Pediatric wide-field fundus photograph; camera: Natus RetCam Envision (130° FOV); 1440x1080: 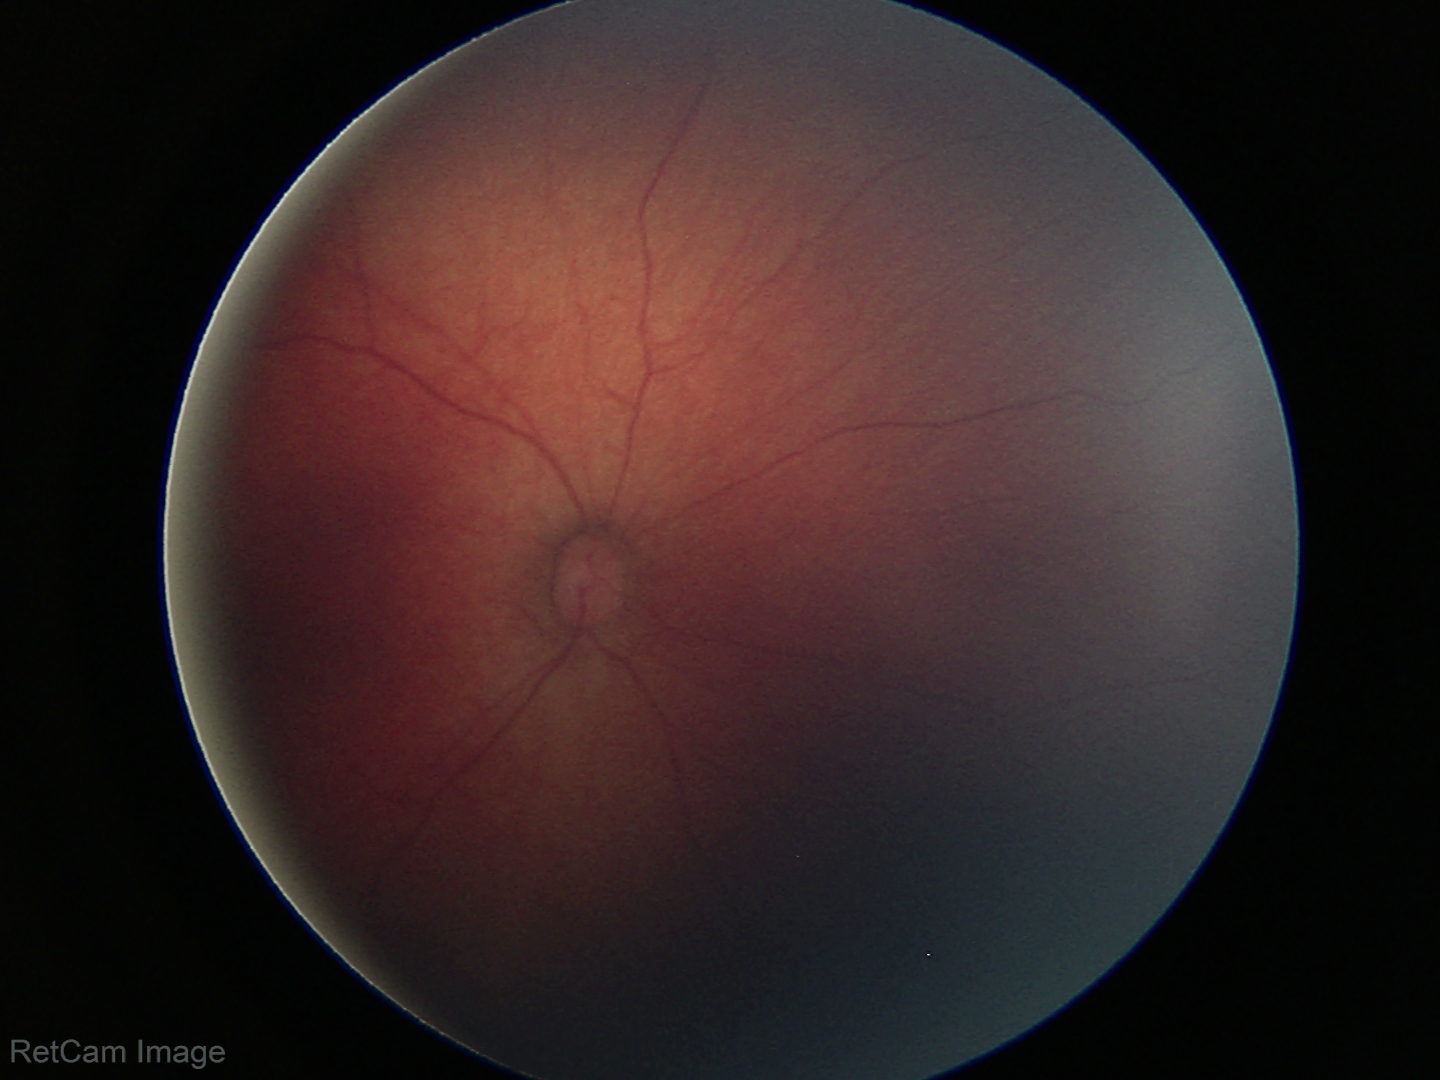 Screening diagnosis: no abnormal retinal findings.